Modified Davis grading — 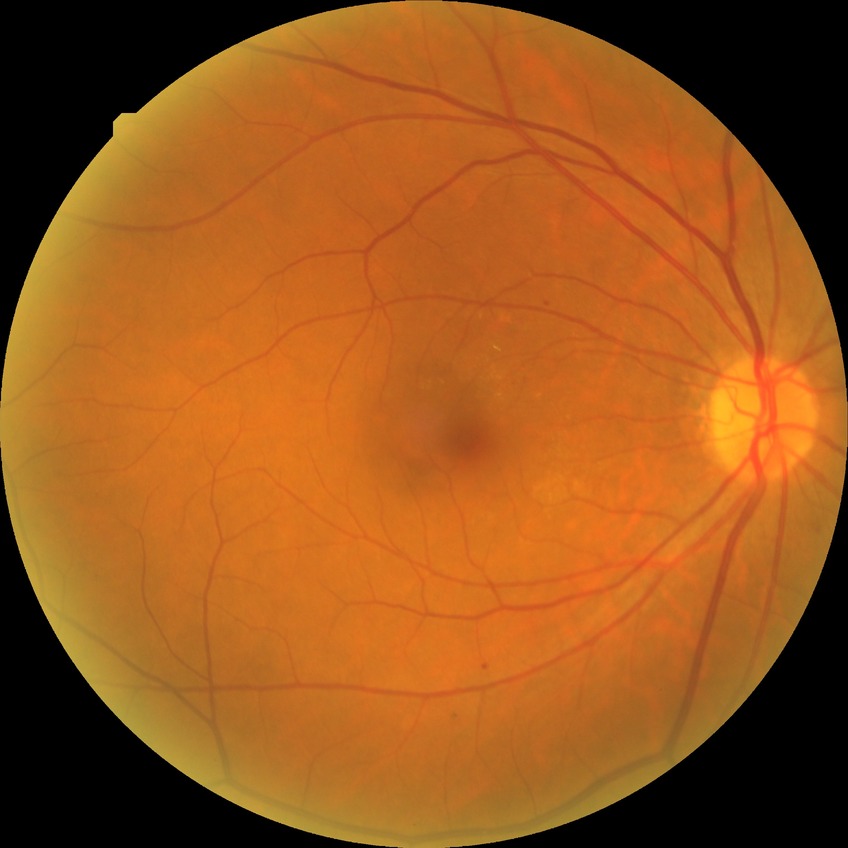

davis_grade: SDR (simple diabetic retinopathy)